1932 by 1932 pixels.
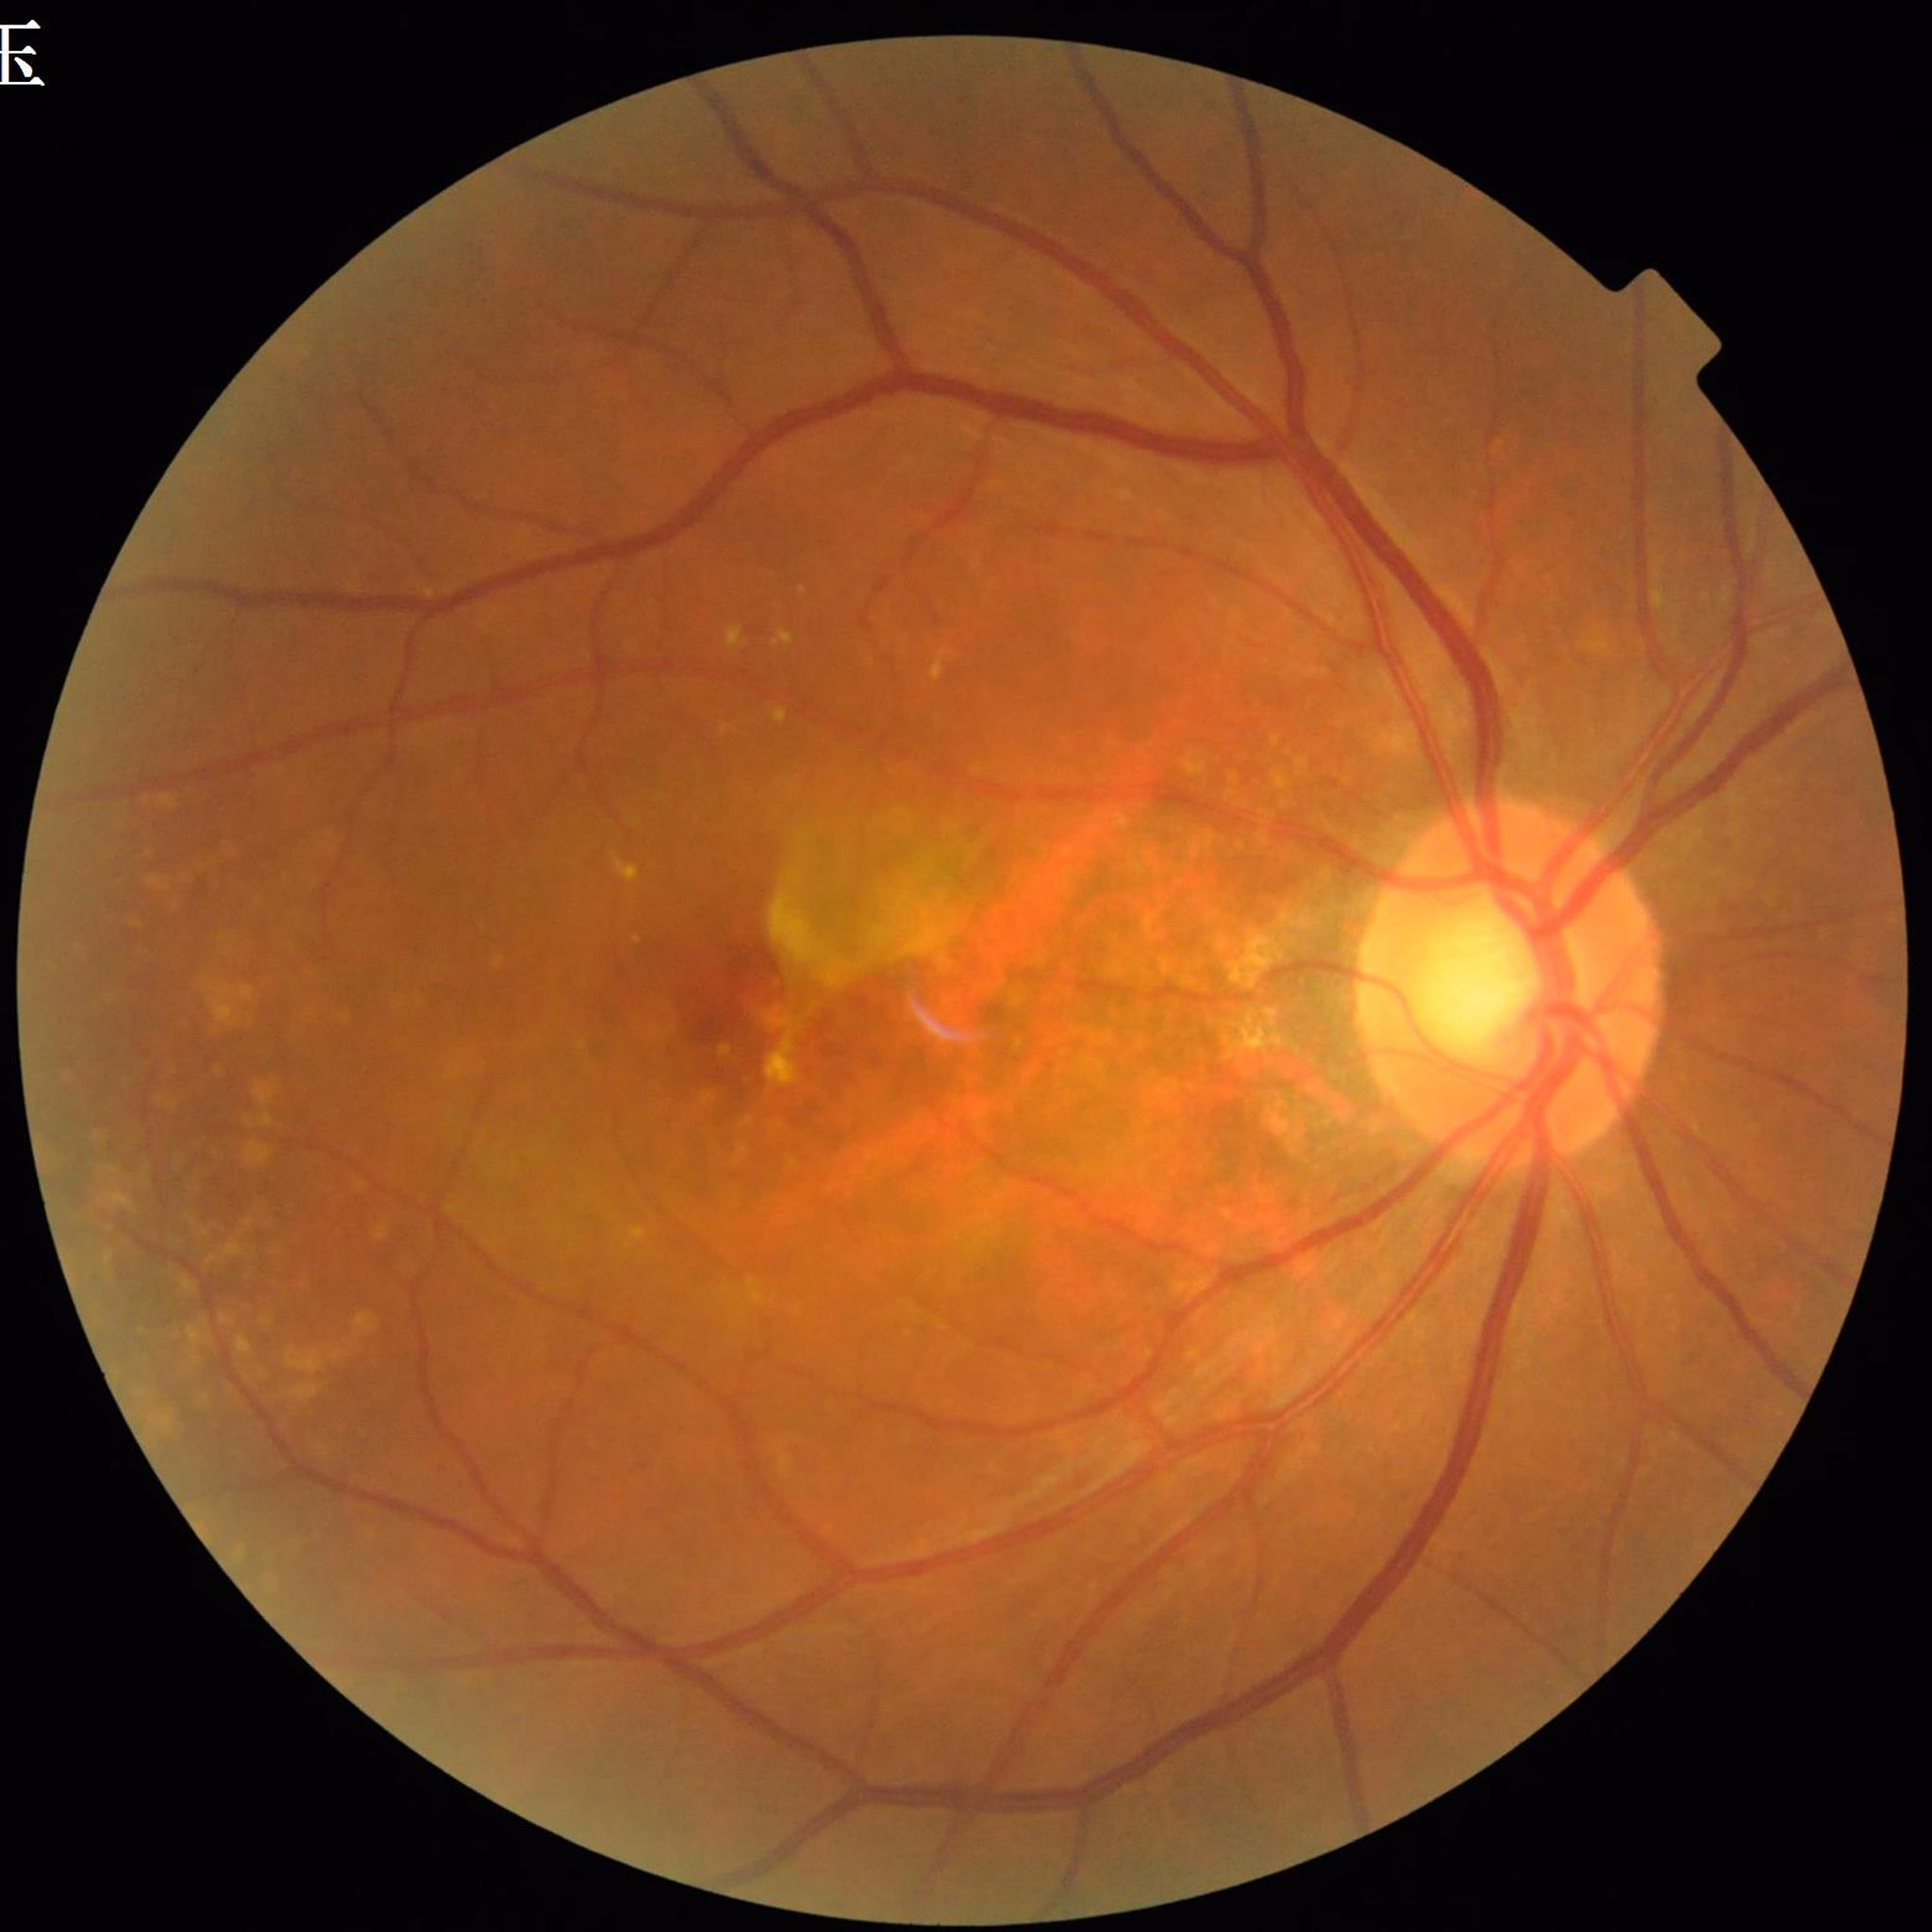

Disease class = AMD